Color fundus image.
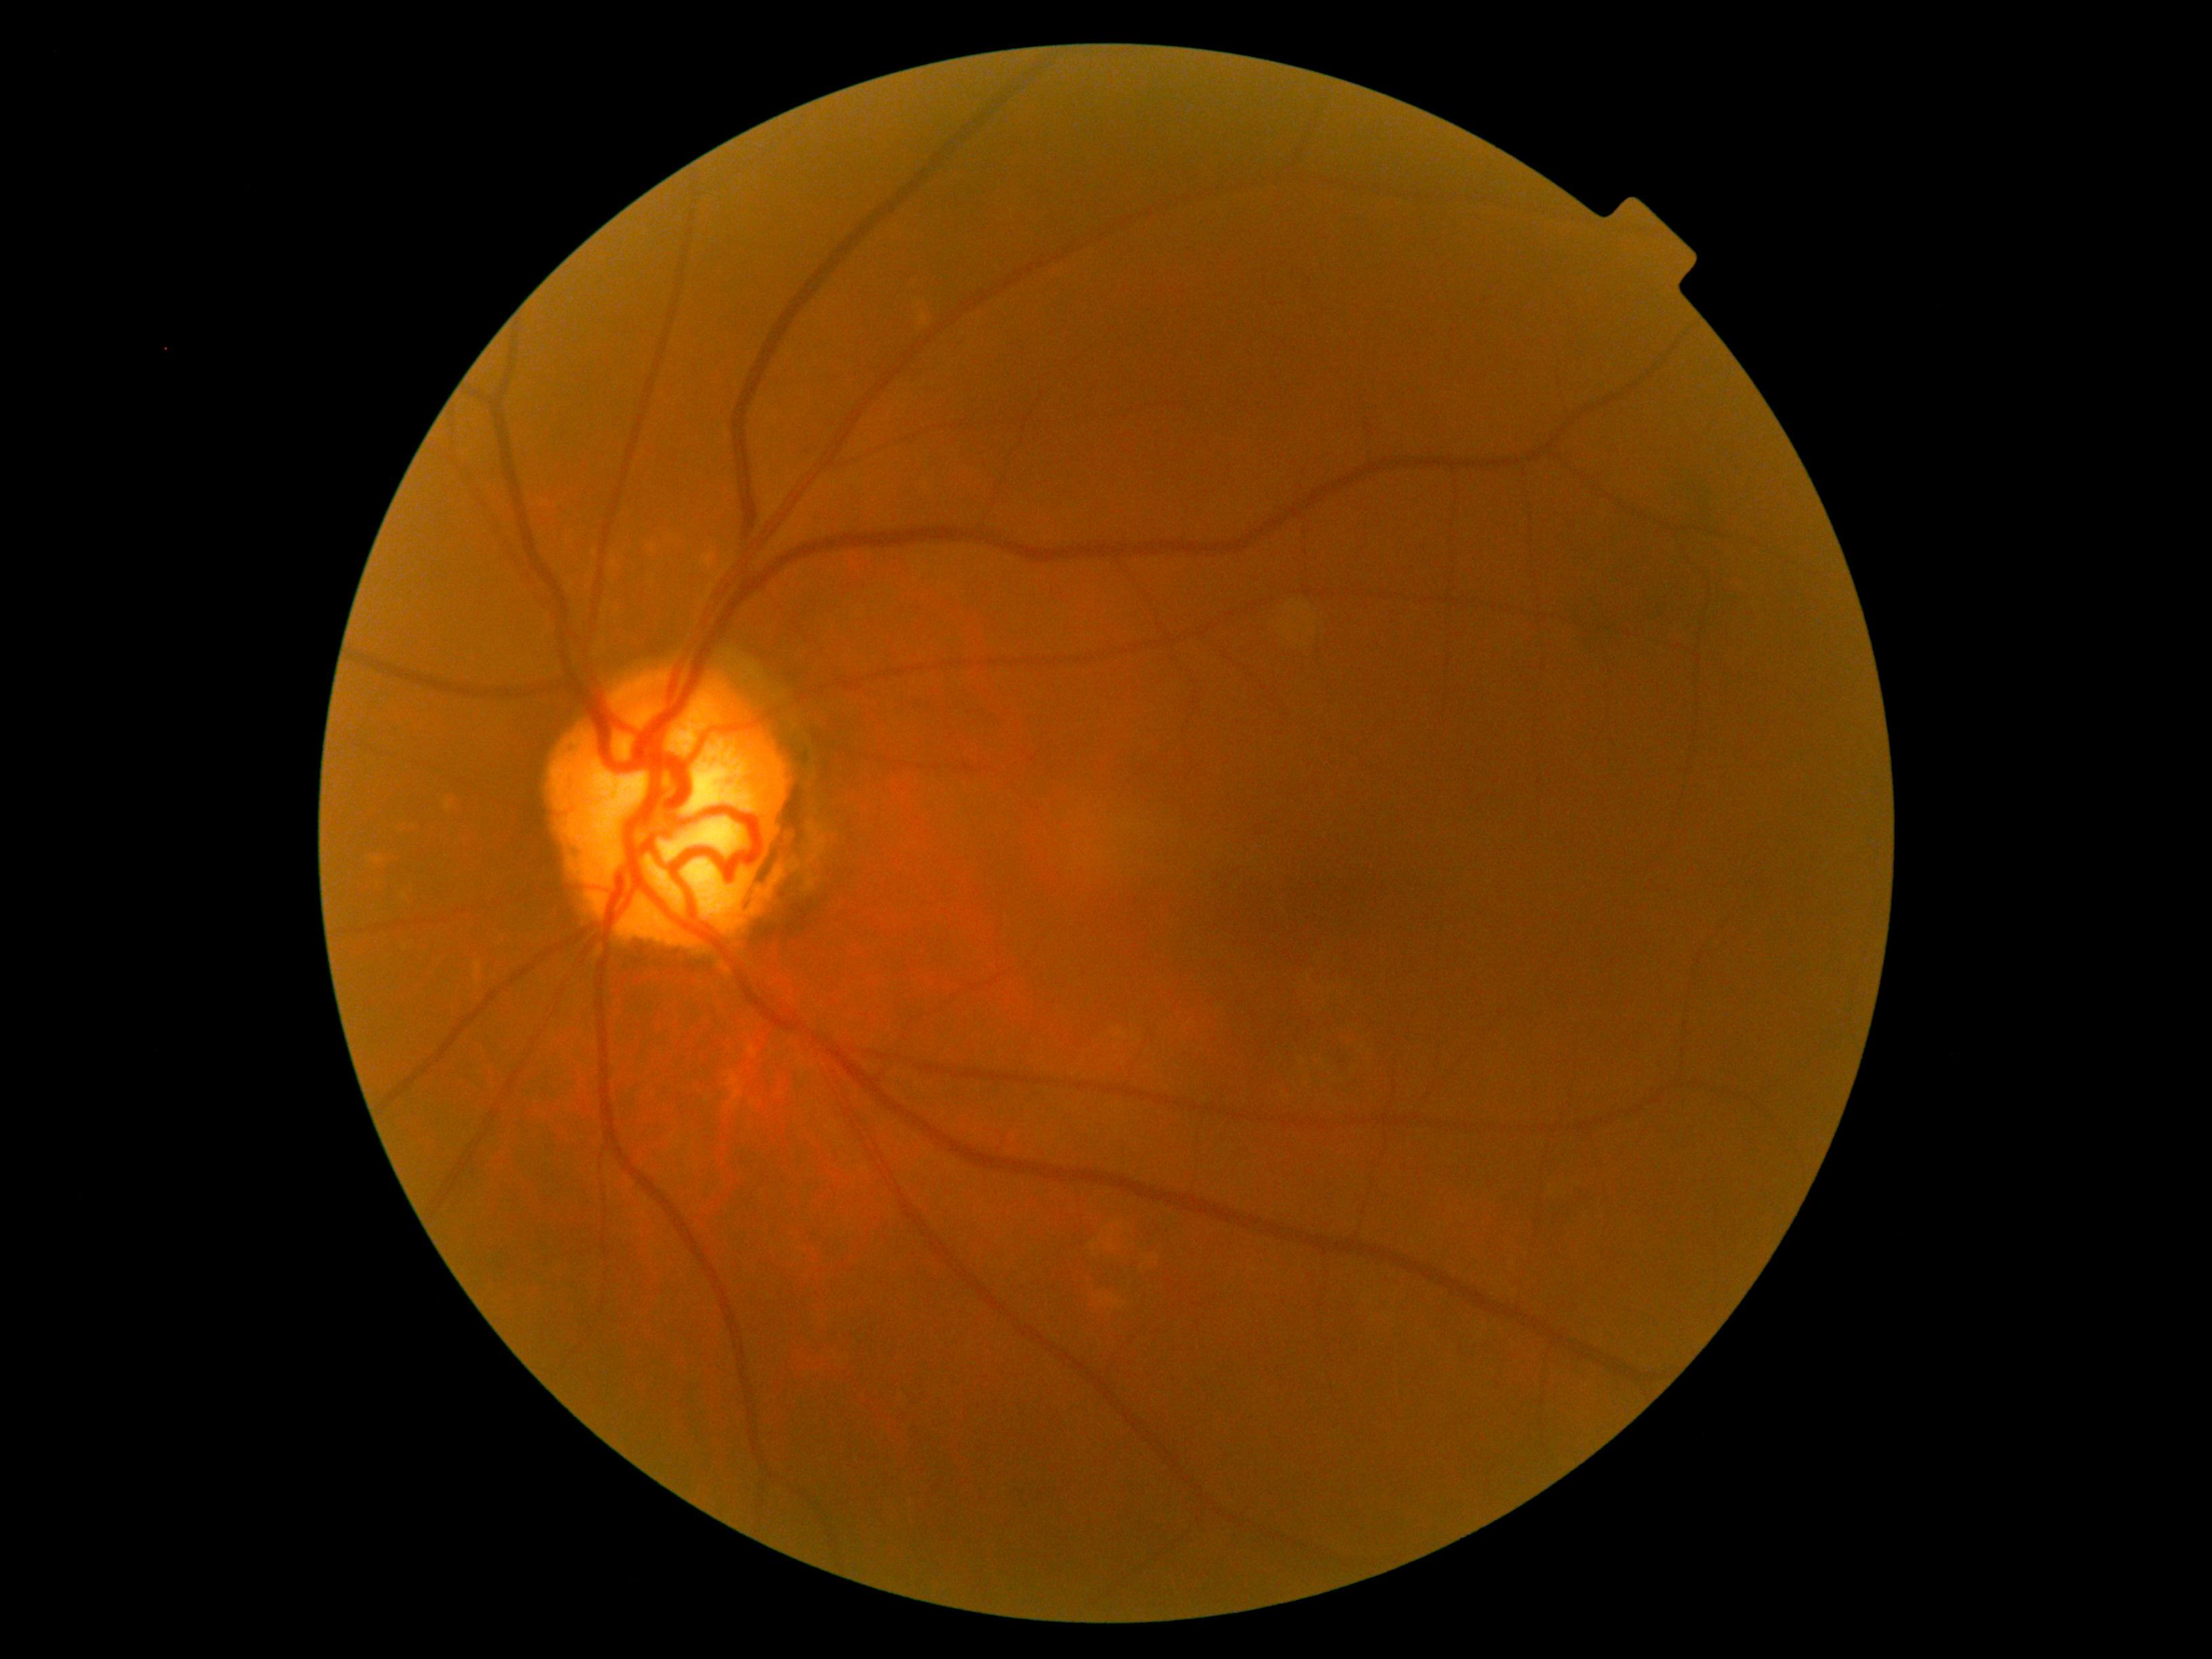
diabetic retinopathy=grade 0 — no visible signs of diabetic retinopathy.